640x480px · pediatric retinal photograph (wide-field):
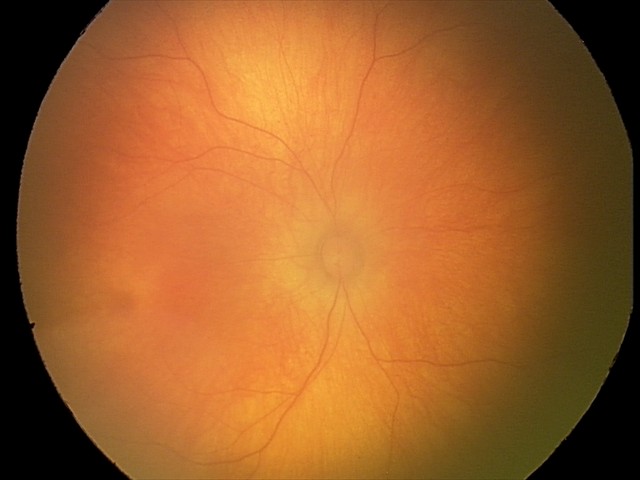

No retinal pathology identified on screening.